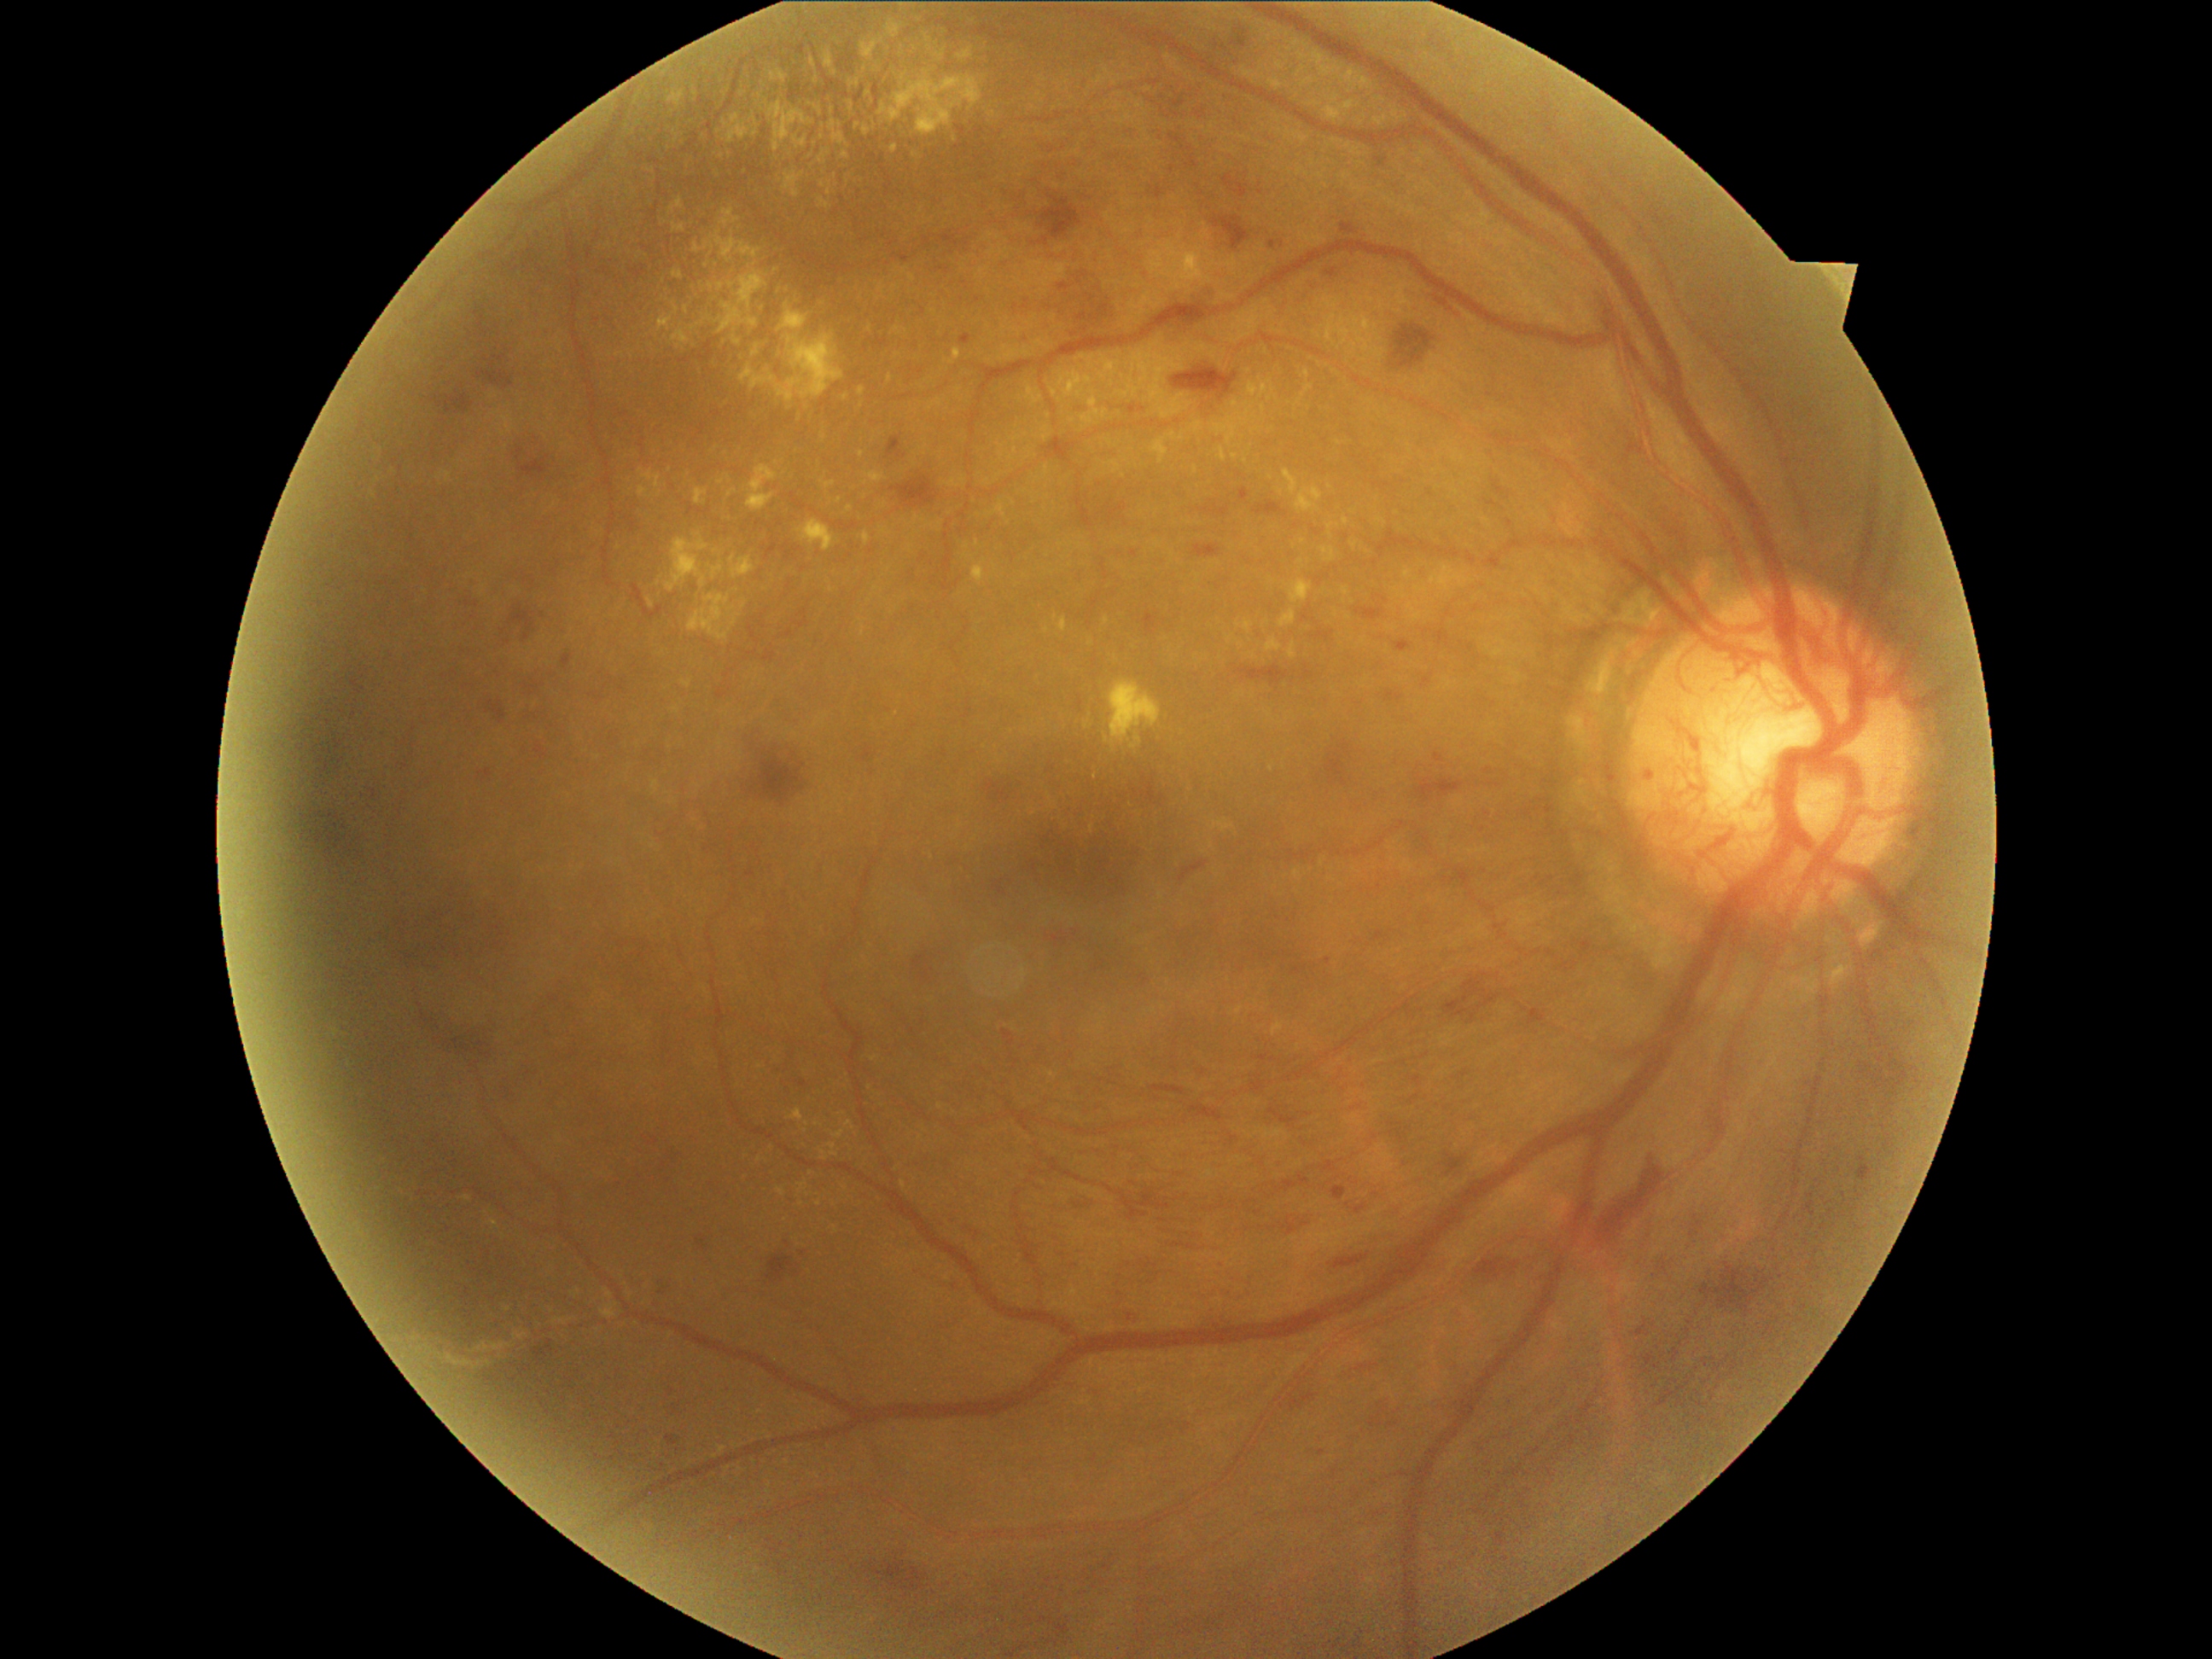
Diabetic retinopathy (DR): PDR (grade 4)
Representative lesions:
hard exudates (EXs) (continued) = box(822, 1151, 827, 1160), box(1327, 523, 1334, 538), box(446, 1354, 475, 1368), box(667, 91, 685, 107), box(777, 1189, 786, 1197), box(747, 465, 779, 511), box(952, 349, 962, 364), box(1300, 54, 1307, 62), box(813, 107, 824, 115), box(1266, 637, 1283, 651), box(648, 600, 655, 608), box(1243, 620, 1254, 632), box(750, 114, 759, 137), box(907, 20, 936, 42)
Small EXs near Point(1297, 43), Point(1255, 417), Point(828, 192), Point(676, 310), Point(734, 330), Point(858, 126)